CFP. 2352 by 1568 pixels
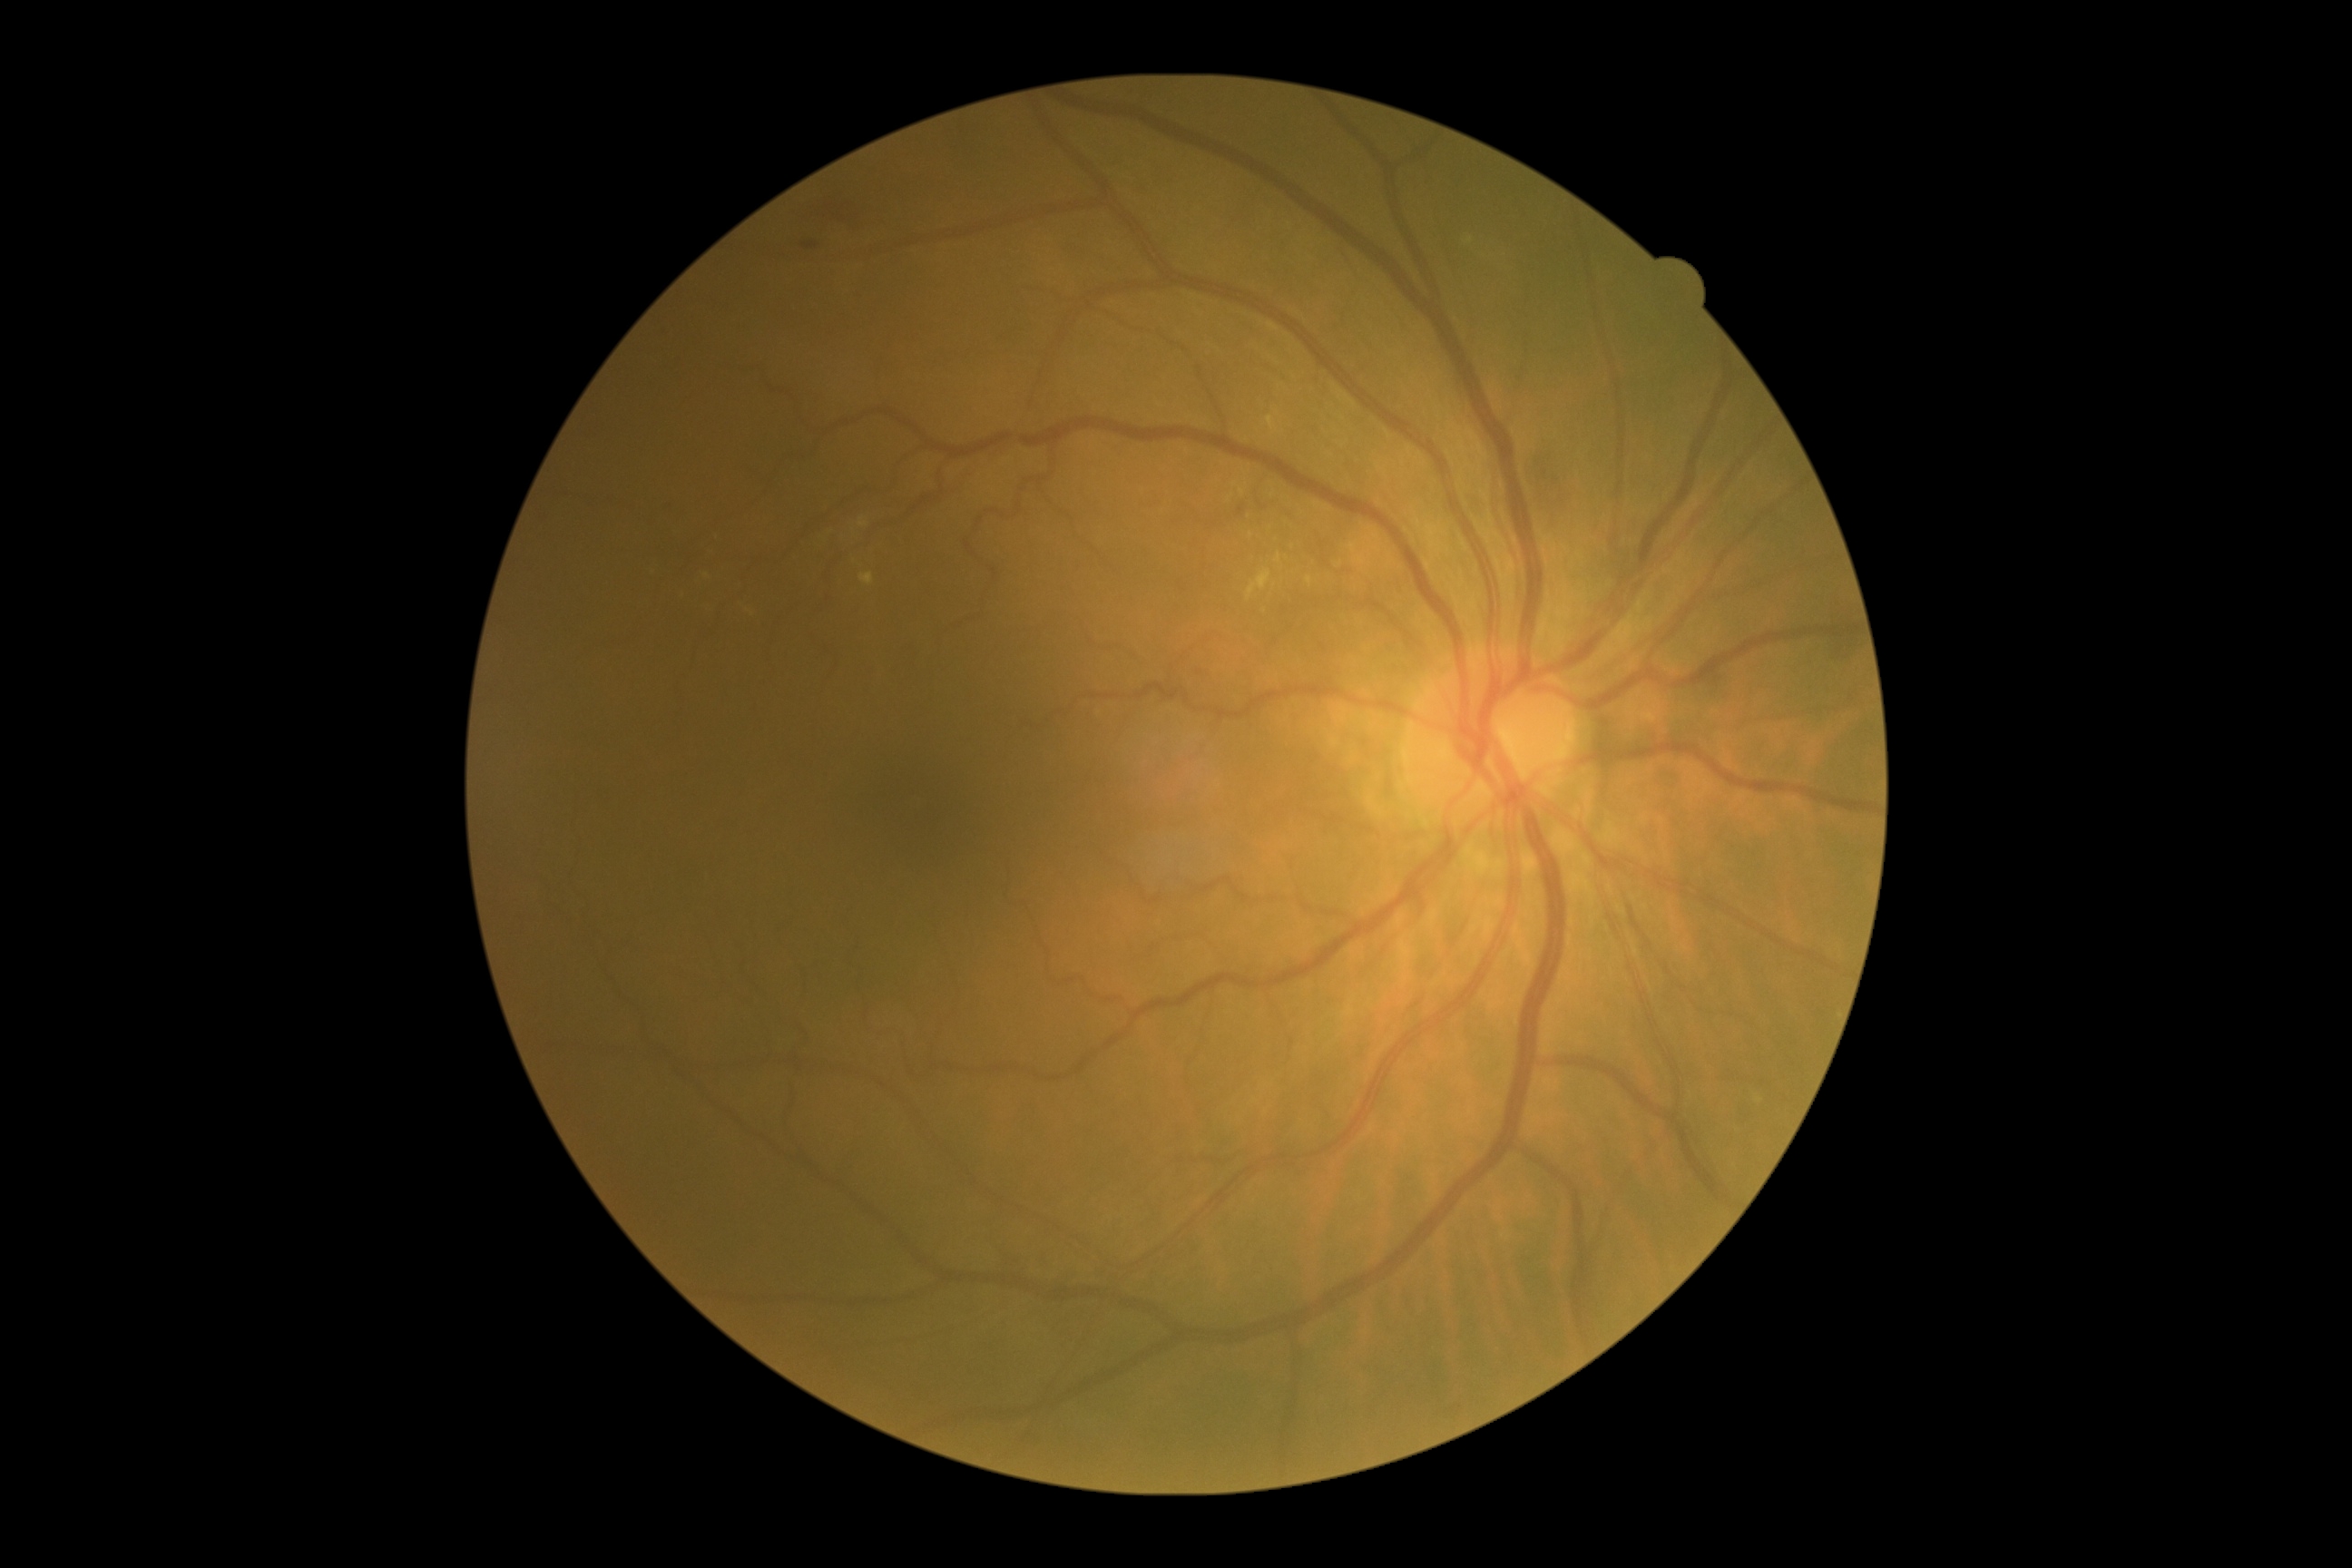 DR severity is grade 2 (moderate NPDR).